130° field of view (Clarity RetCam 3). Wide-field fundus photograph of an infant — 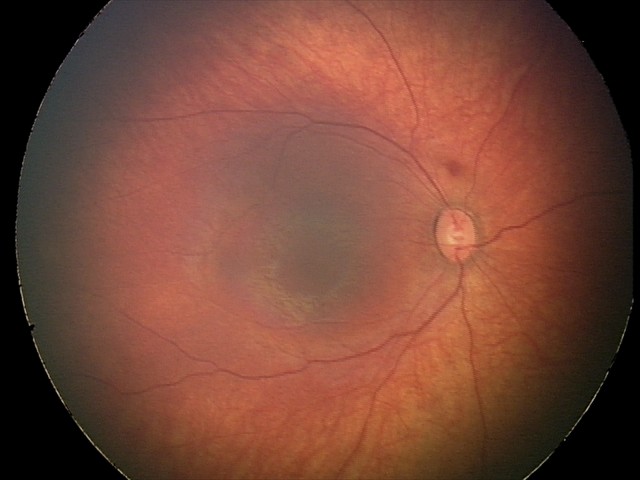

From an examination with diagnosis of retinal hemorrhages.